Wide-field contact fundus photograph of an infant · 130° field of view (Natus RetCam Envision):
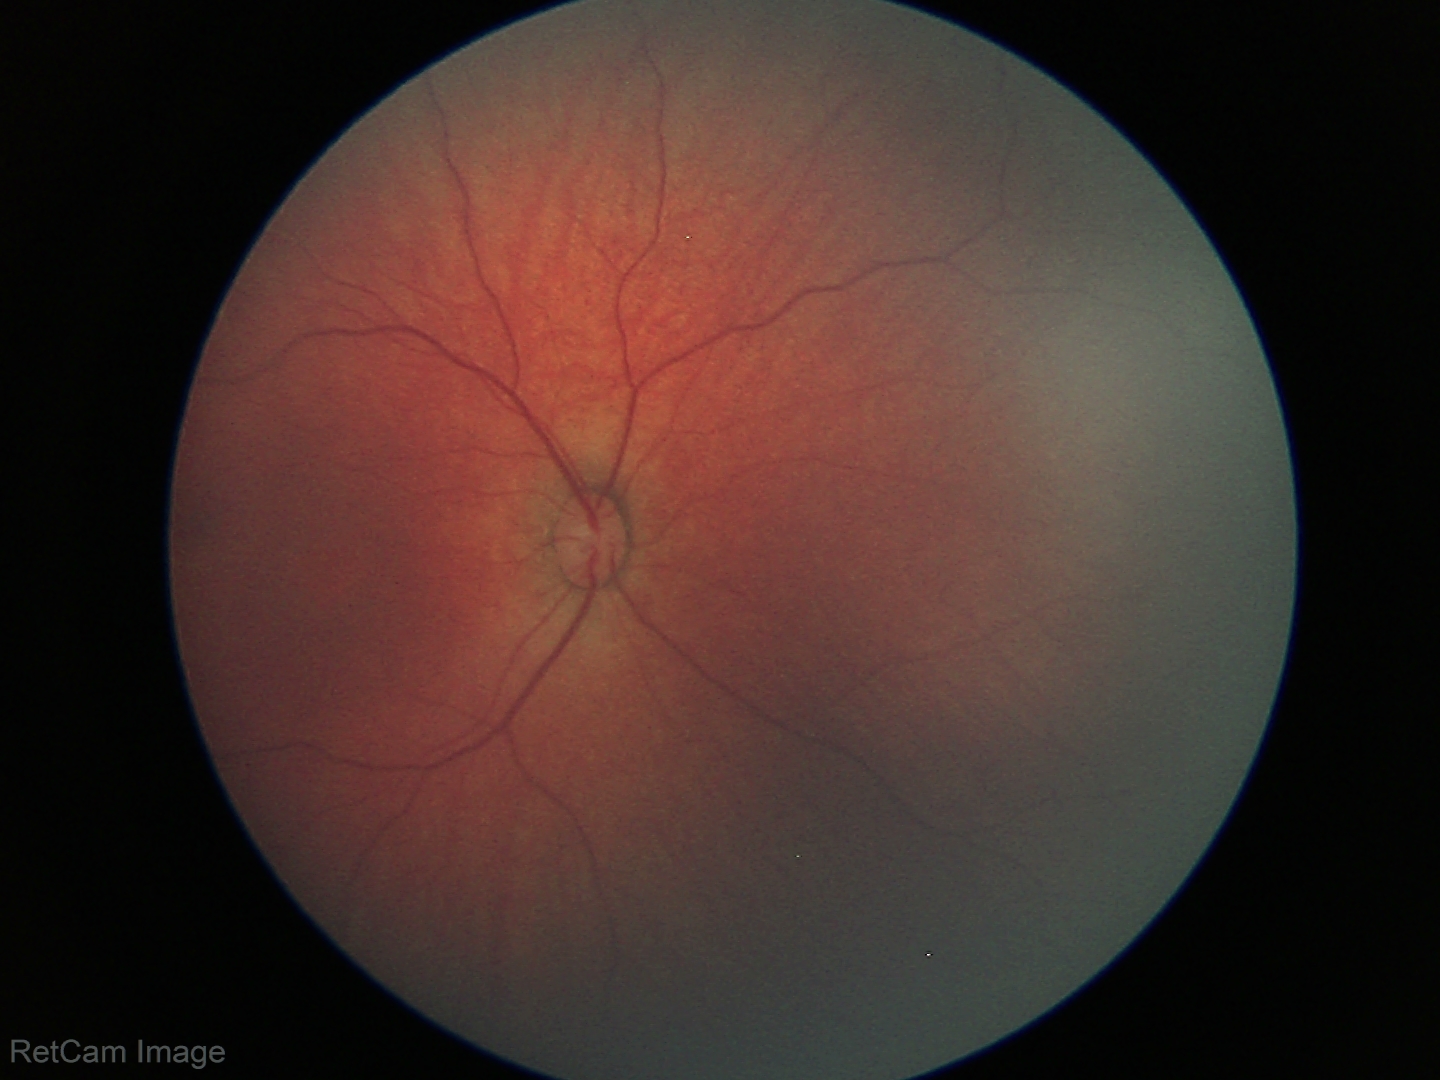 Q: What is the diagnosis from this examination?
A: physiological retinal finding